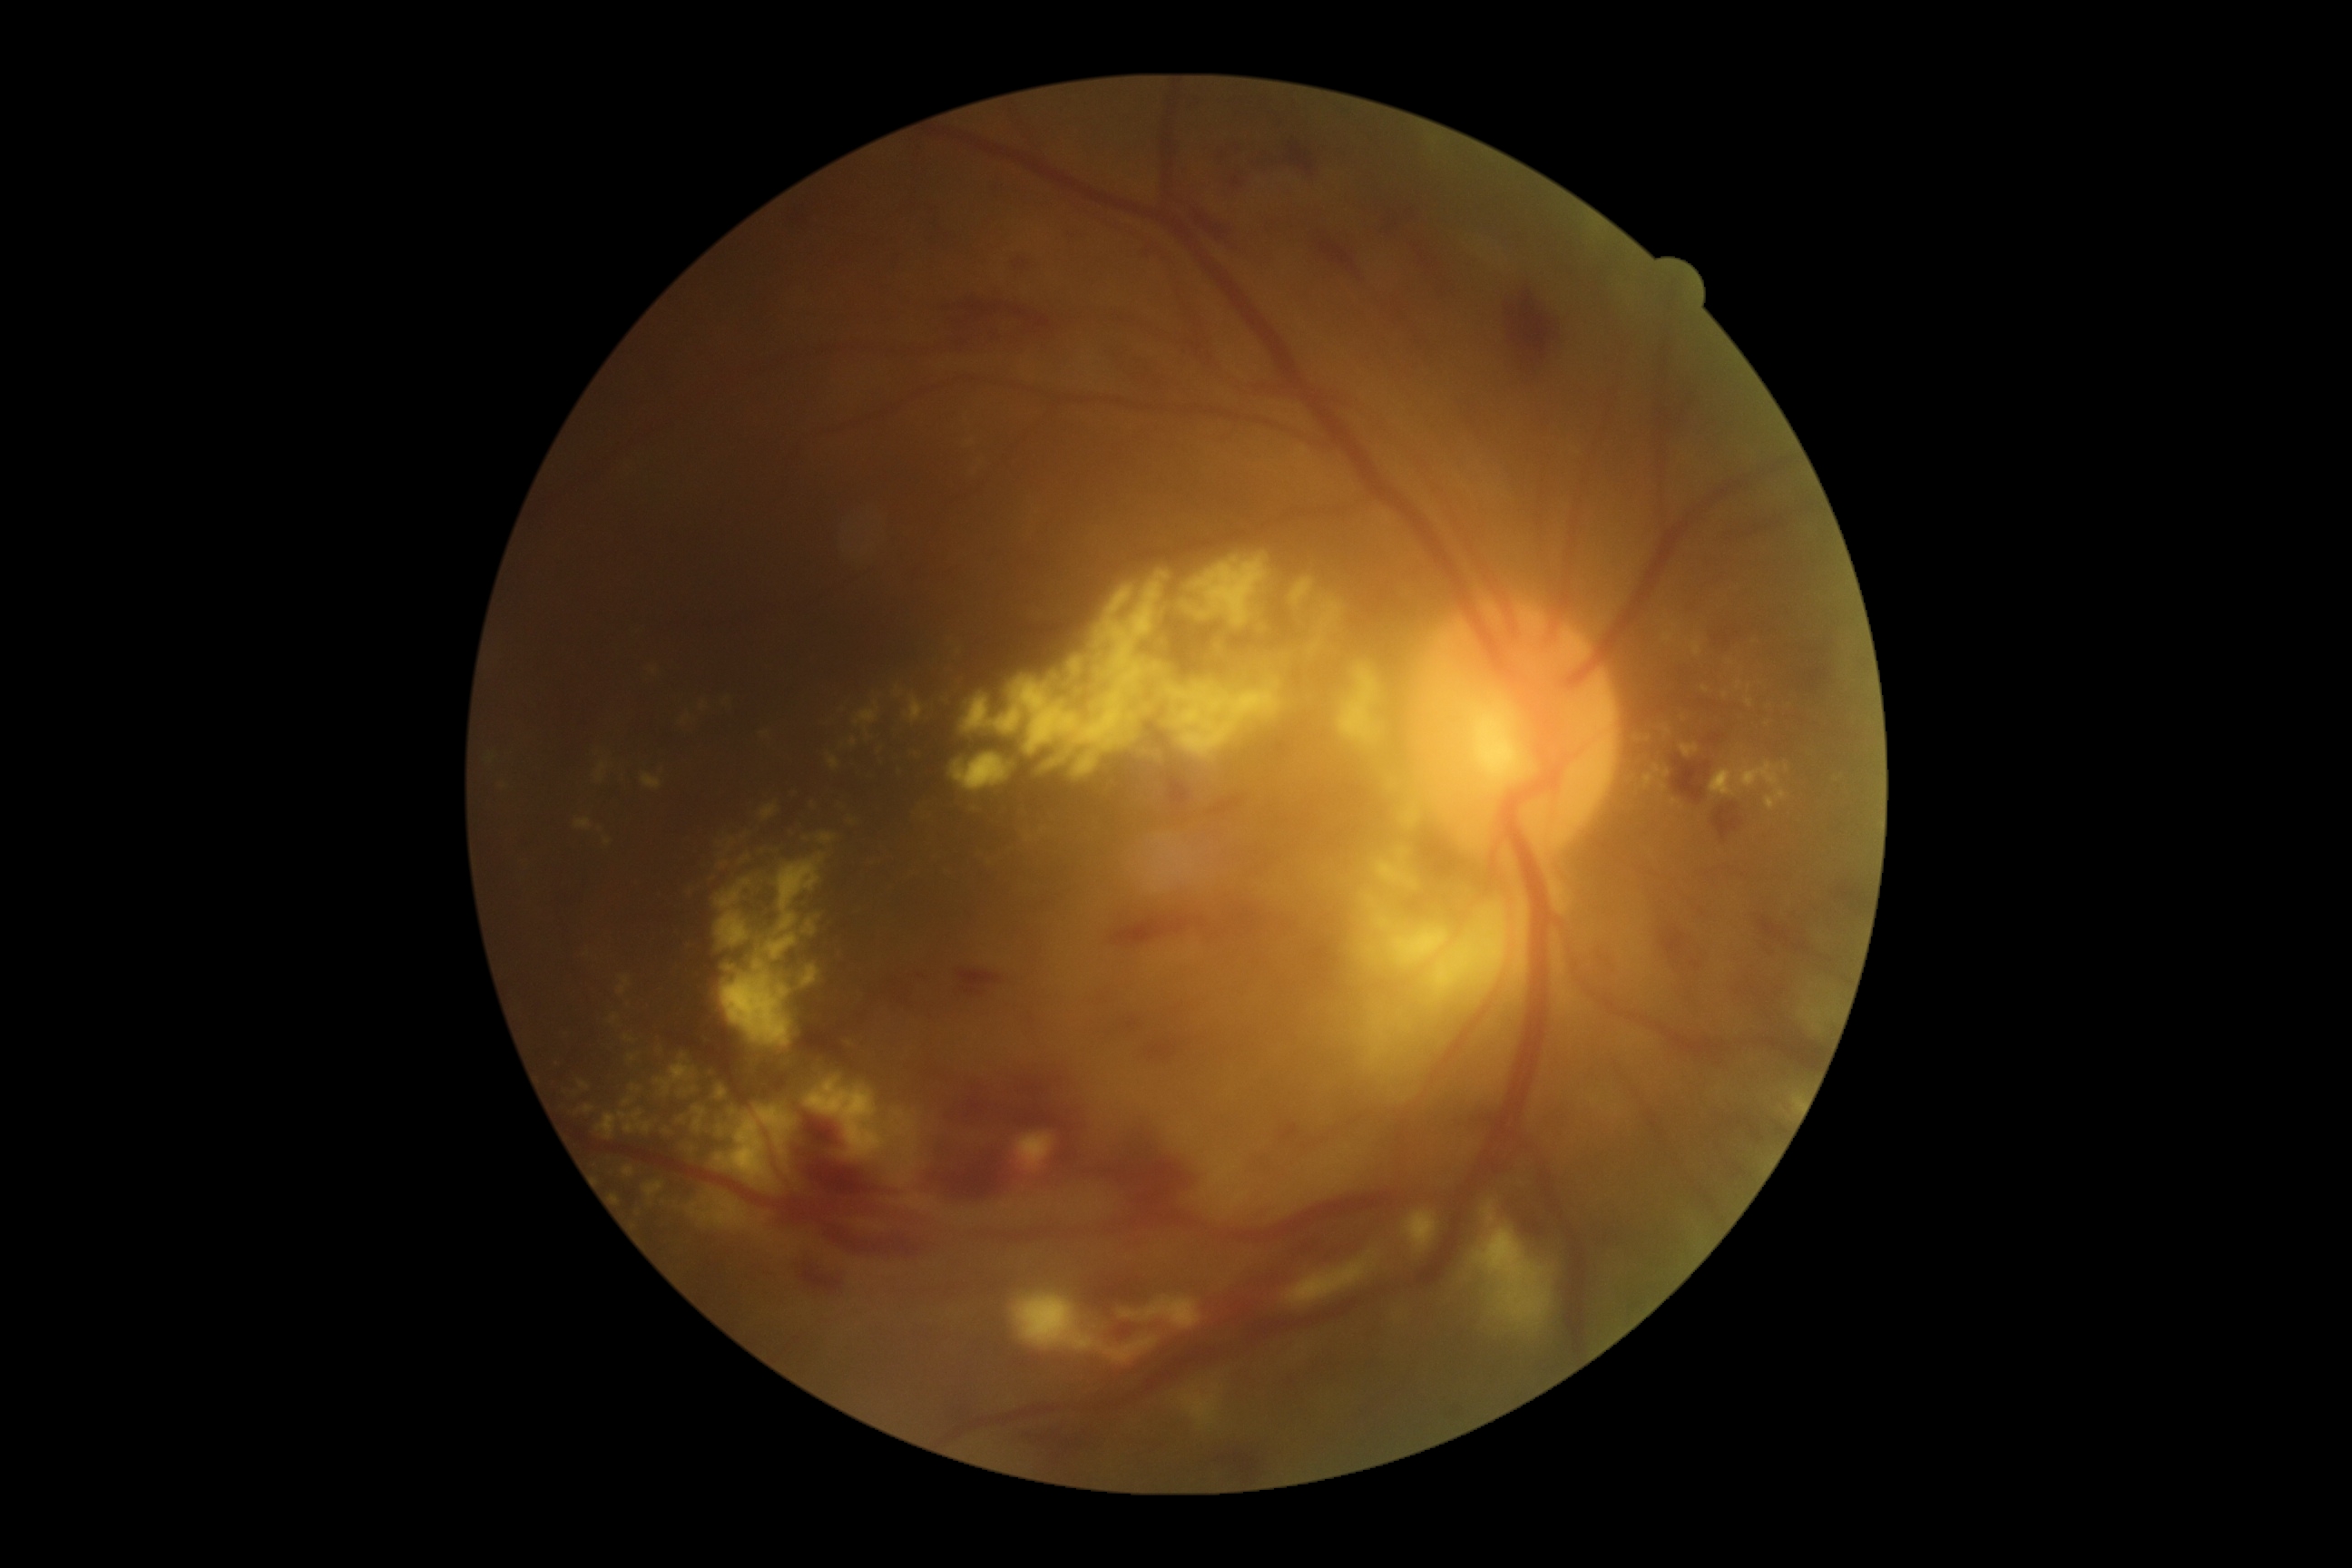

diabetic retinopathy (DR): 3.